848x848px; NIDEK AFC-230 fundus camera; nonmydriatic; retinal fundus photograph; 45-degree field of view — 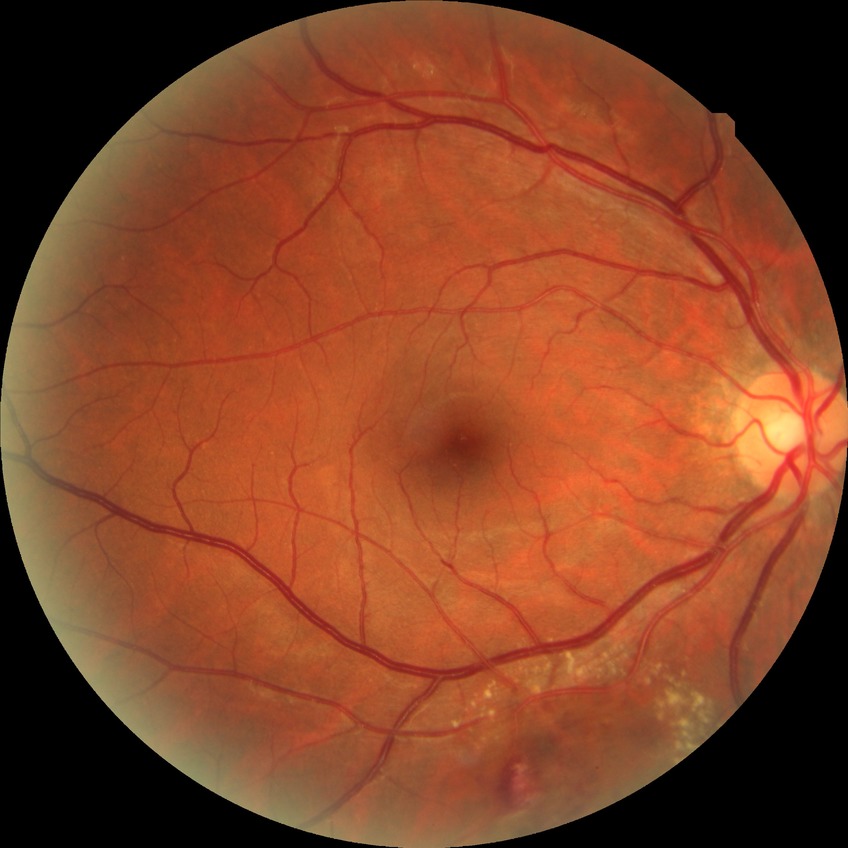 DR: NDR; DR impression: negative for DR.